Retinal fundus photograph; 45° FOV; image size 2352x1568 — 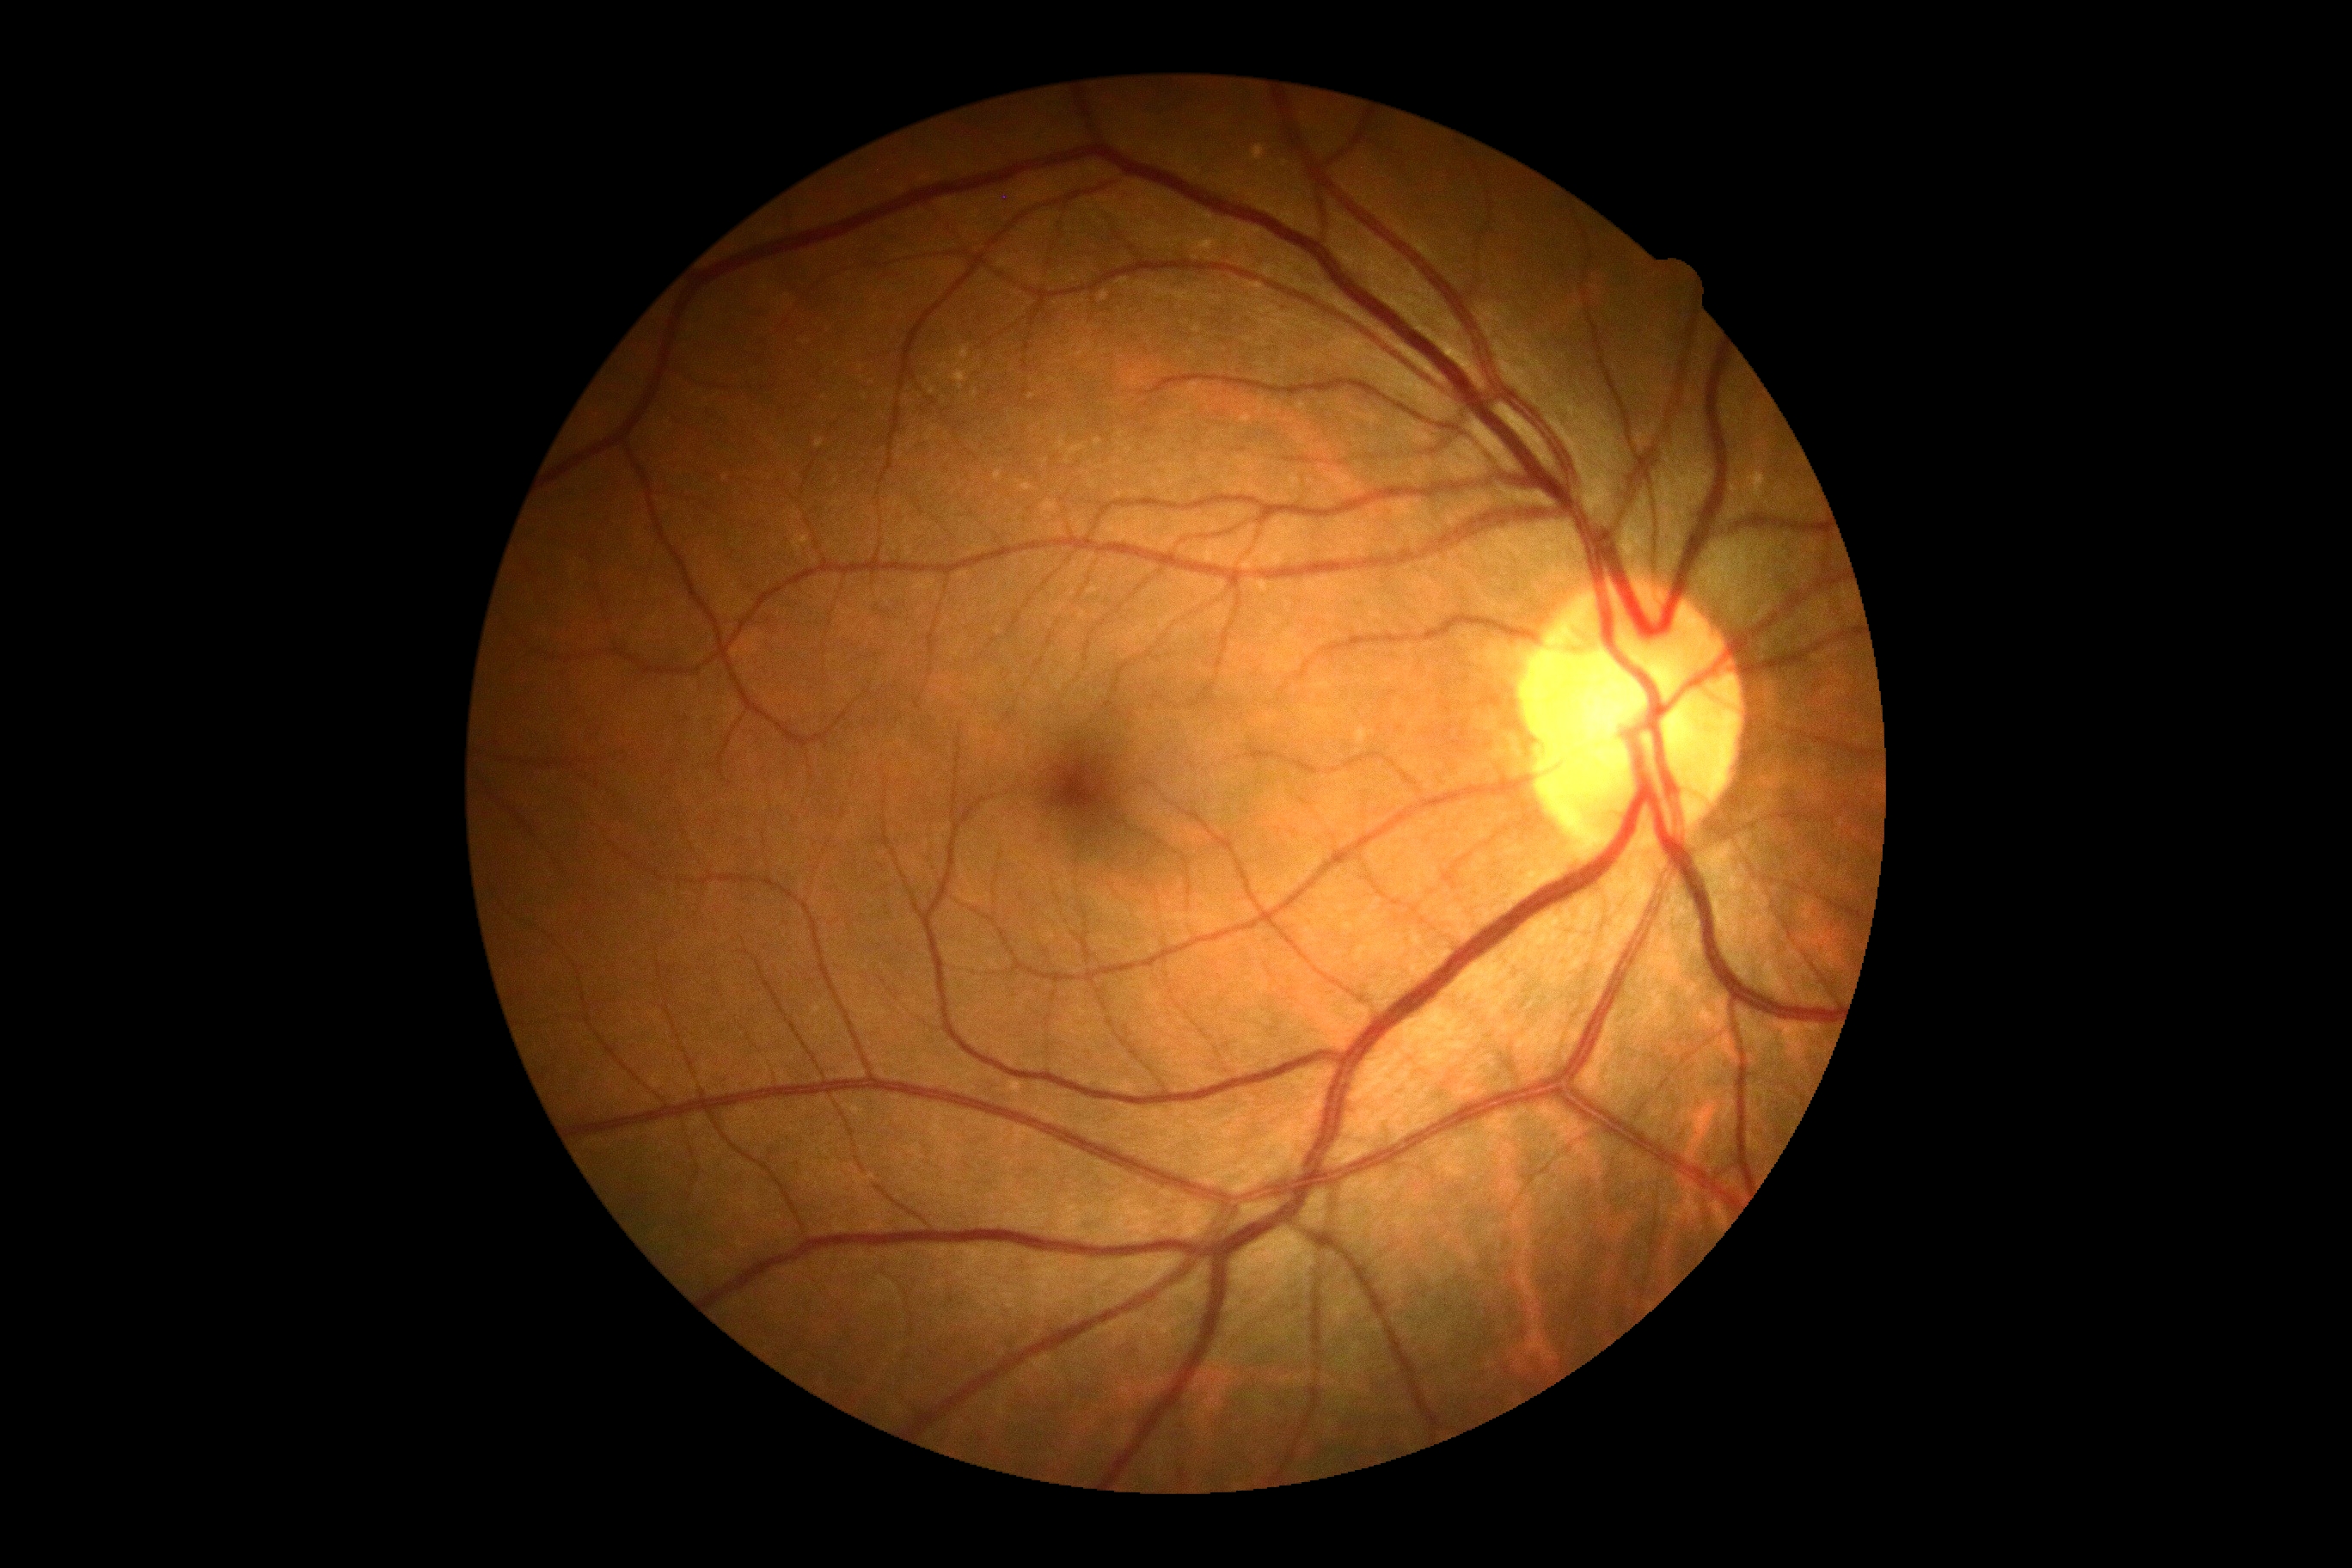

Diabetic retinopathy (DR) is grade 0 (no apparent retinopathy). No DR findings.